640 x 480 pixels. Infant wide-field retinal image. Clarity RetCam 3, 130° FOV:
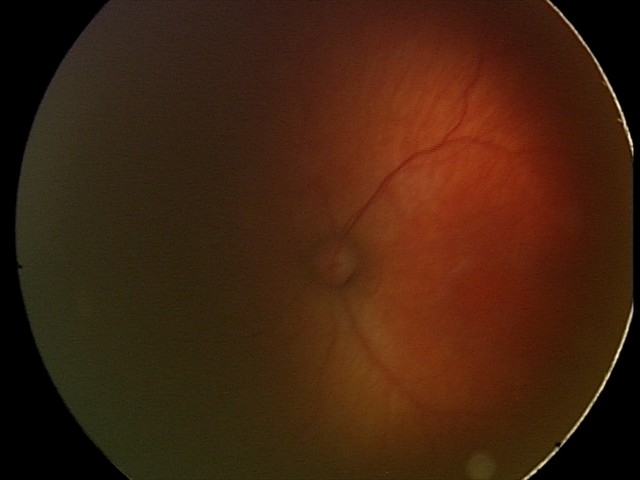

Q: What is the diagnosis from this examination?
A: retinopathy of prematurity stage 2 — ridge with height and width at the demarcation line
Q: Is plus disease present?
A: no plus disease